Wide-field fundus photograph from neonatal ROP screening; Clarity RetCam 3, 130° FOV; 640x480
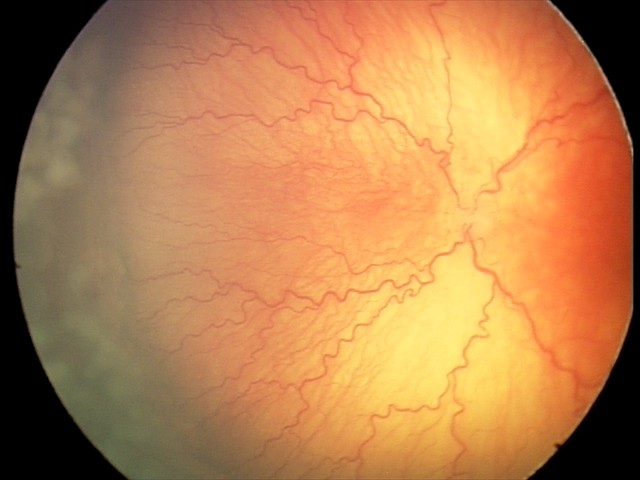
Series diagnosed as A-ROP (aggressive ROP) — rapidly progressive severe ROP with prominent plus disease, often without classic stage progression. Plus disease present.